45-degree field of view: 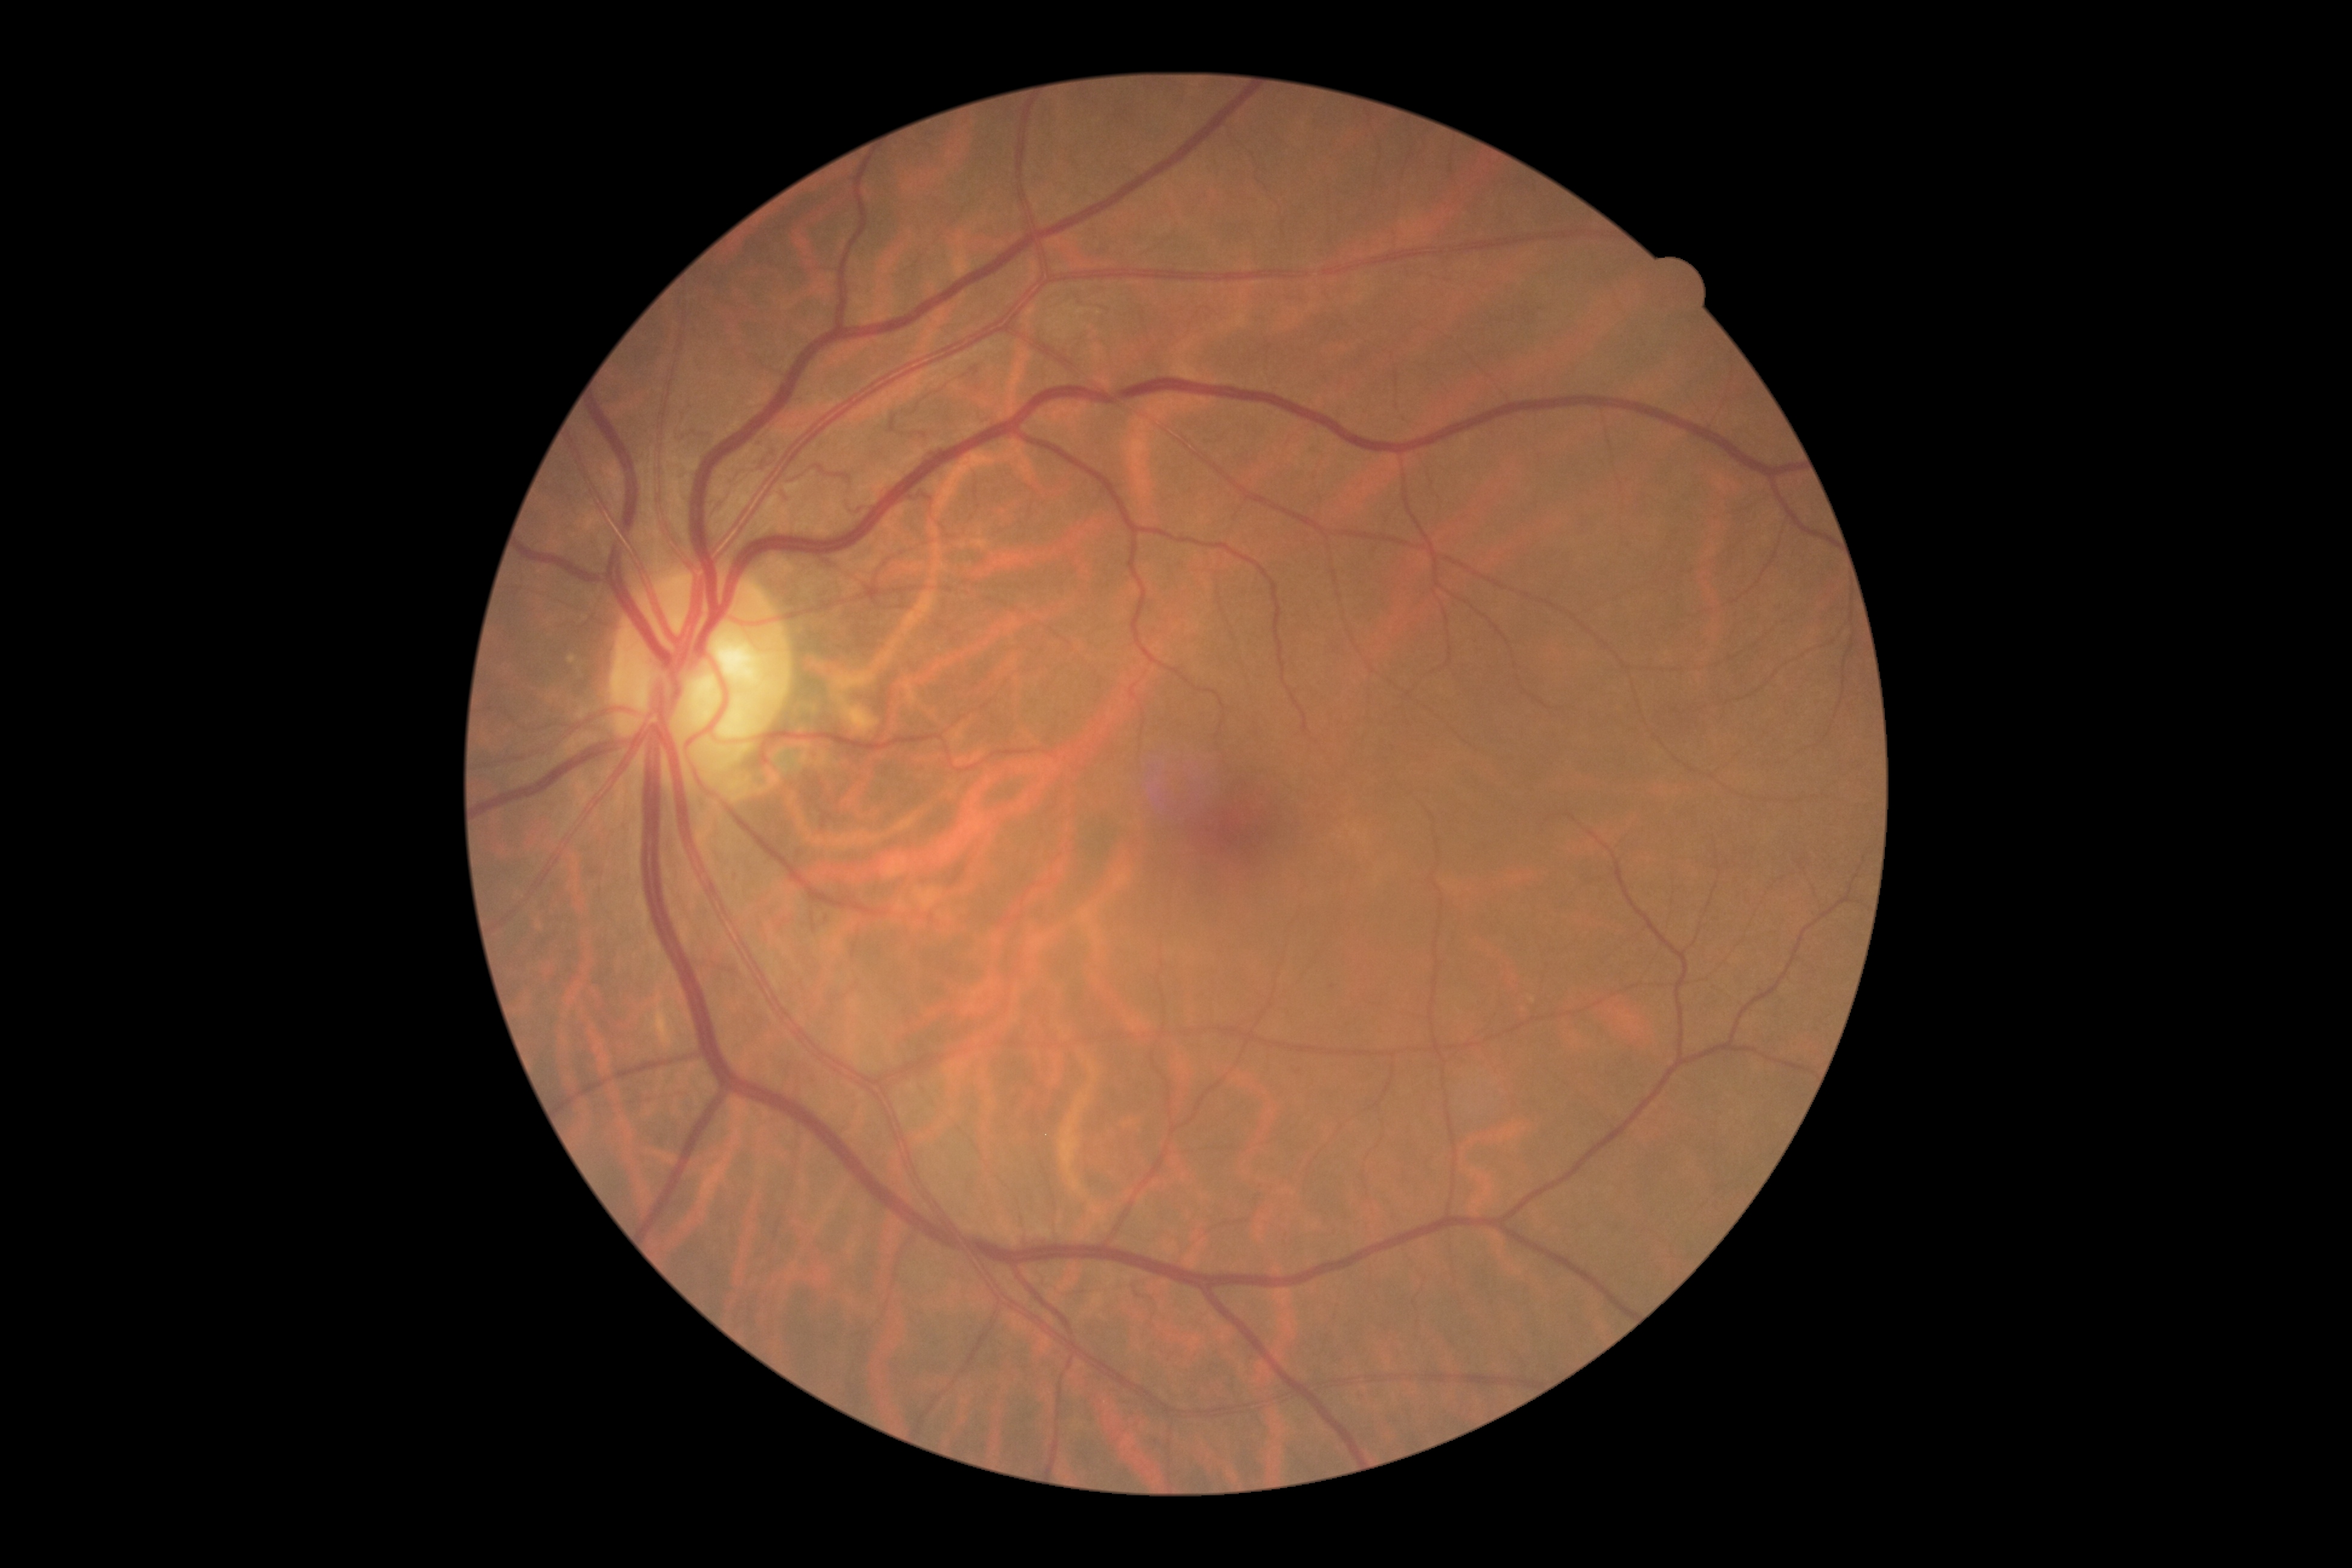

diabetic retinopathy (DR)@grade 0 (no apparent retinopathy).